45-degree field of view · CFP:
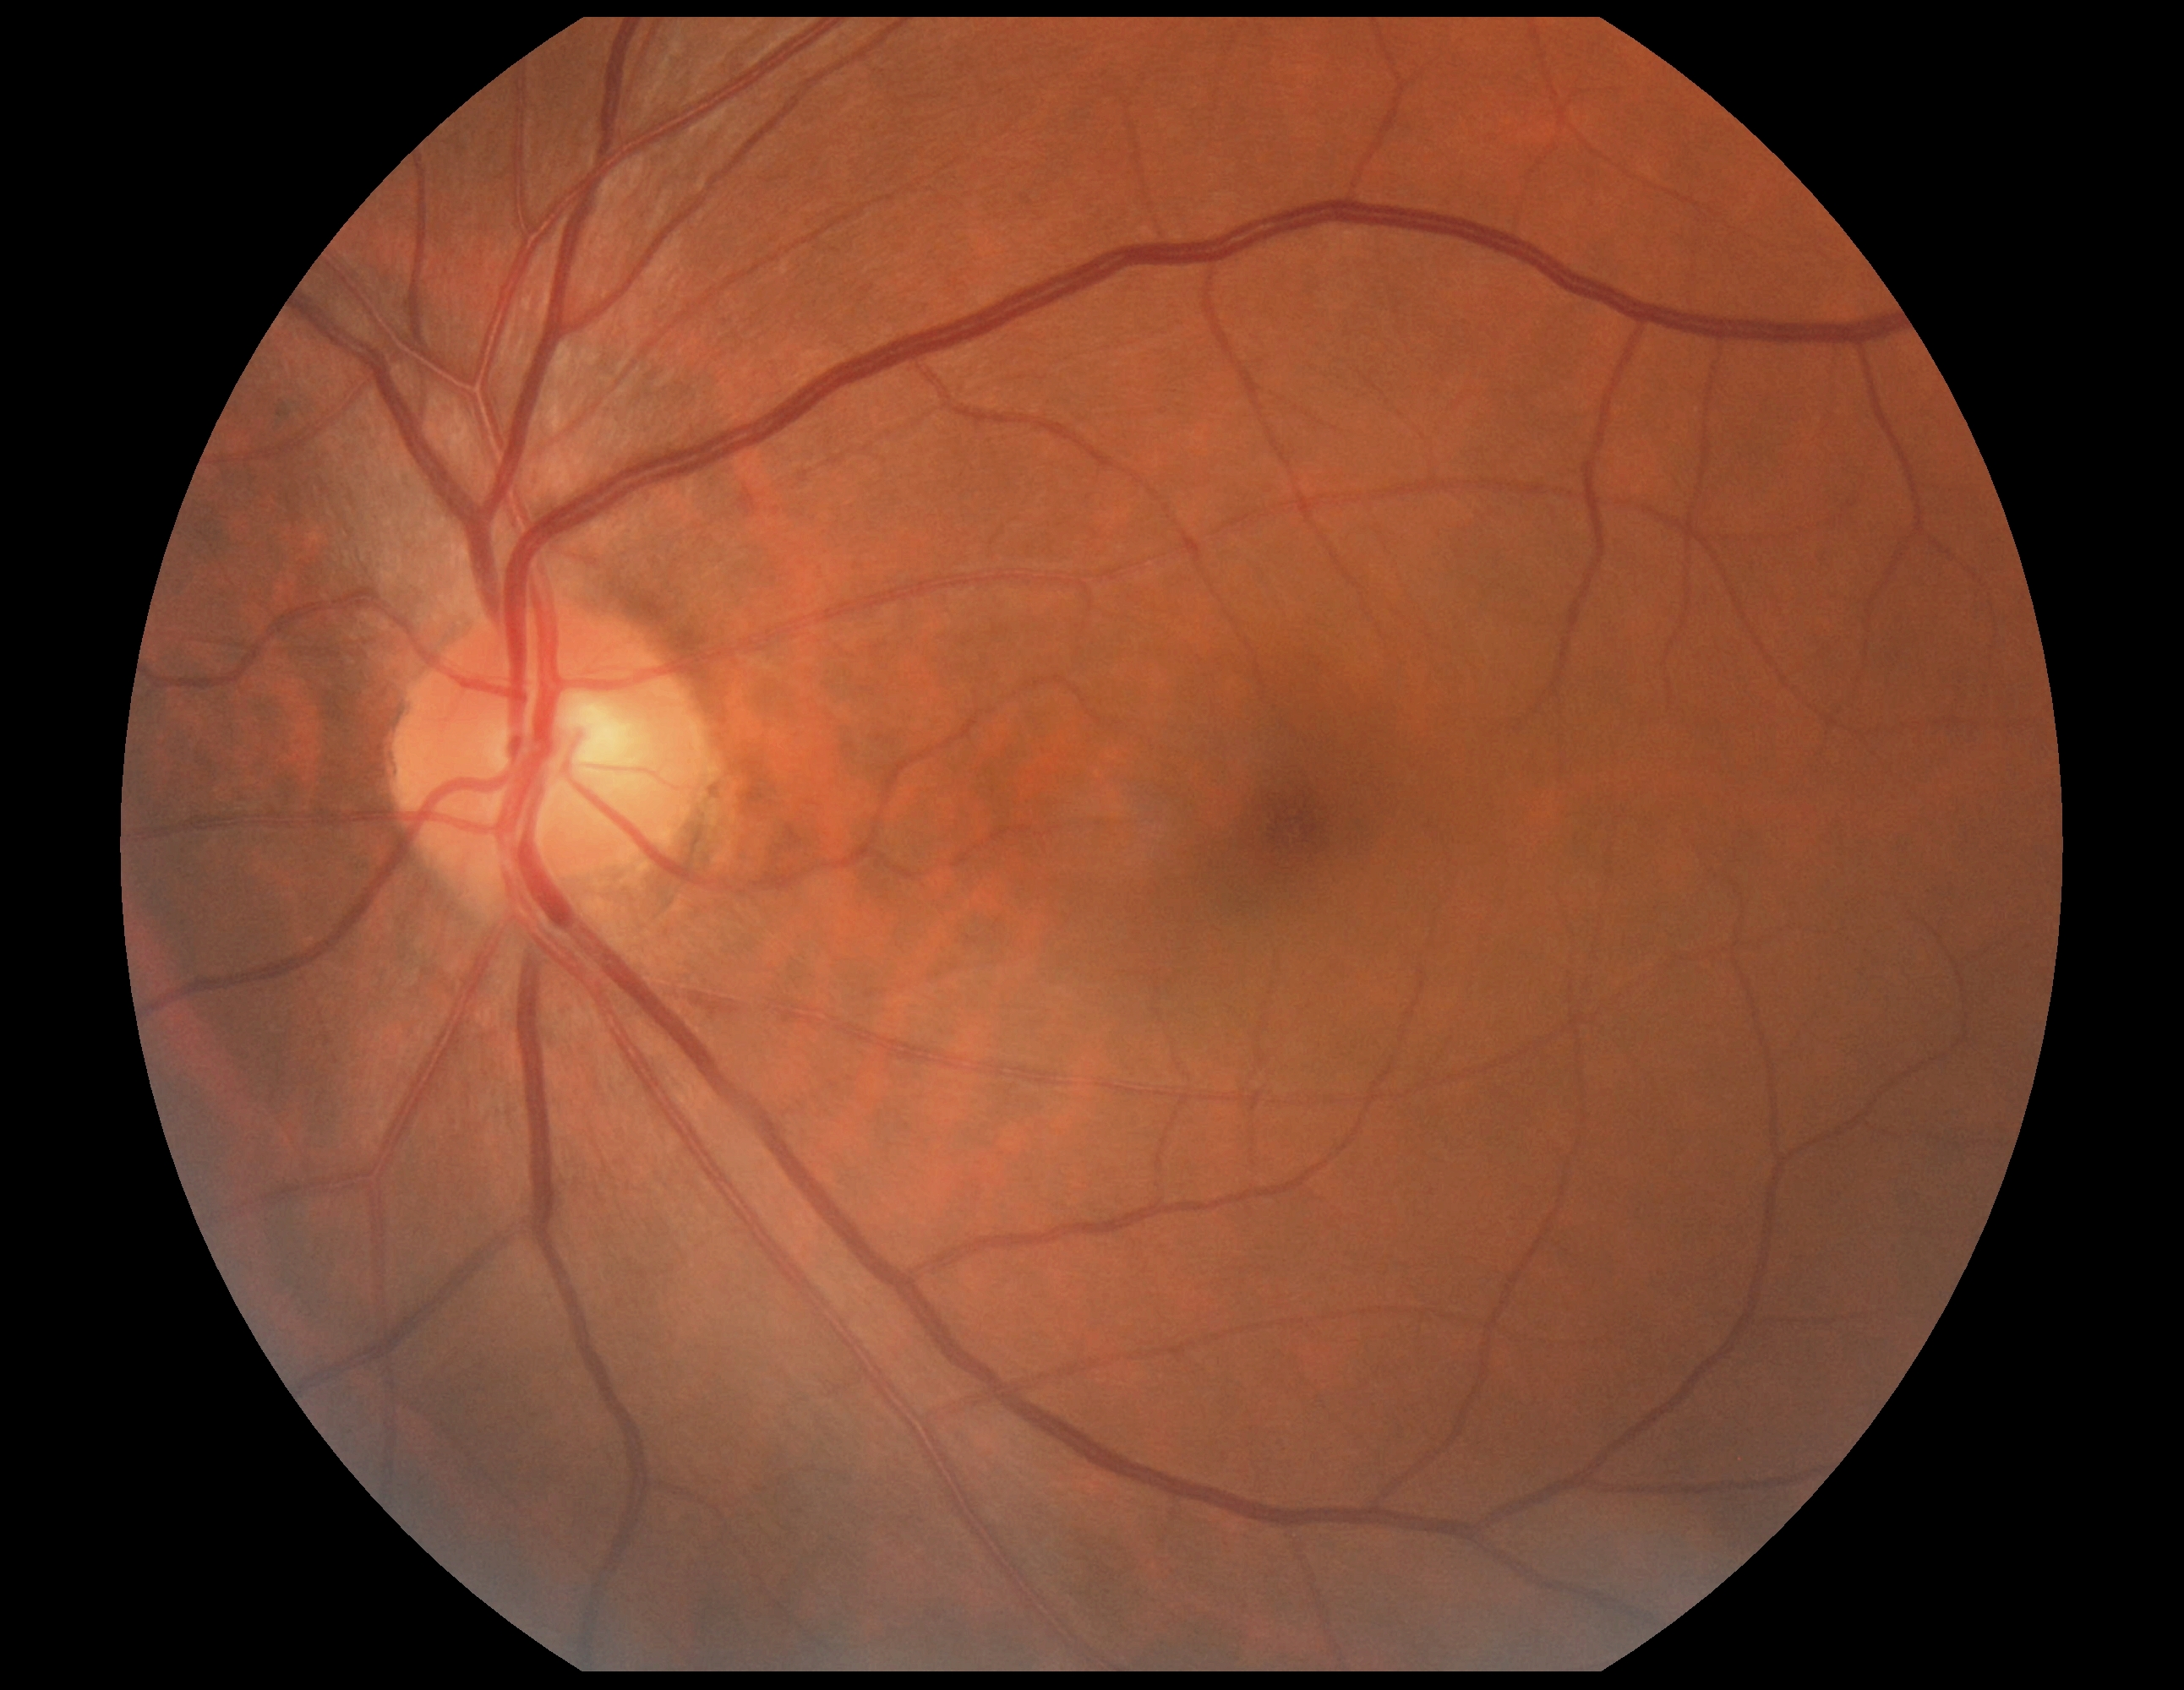

diabetic retinopathy (DR): grade 0.